CFP · 2352x1568 · 45-degree field of view.
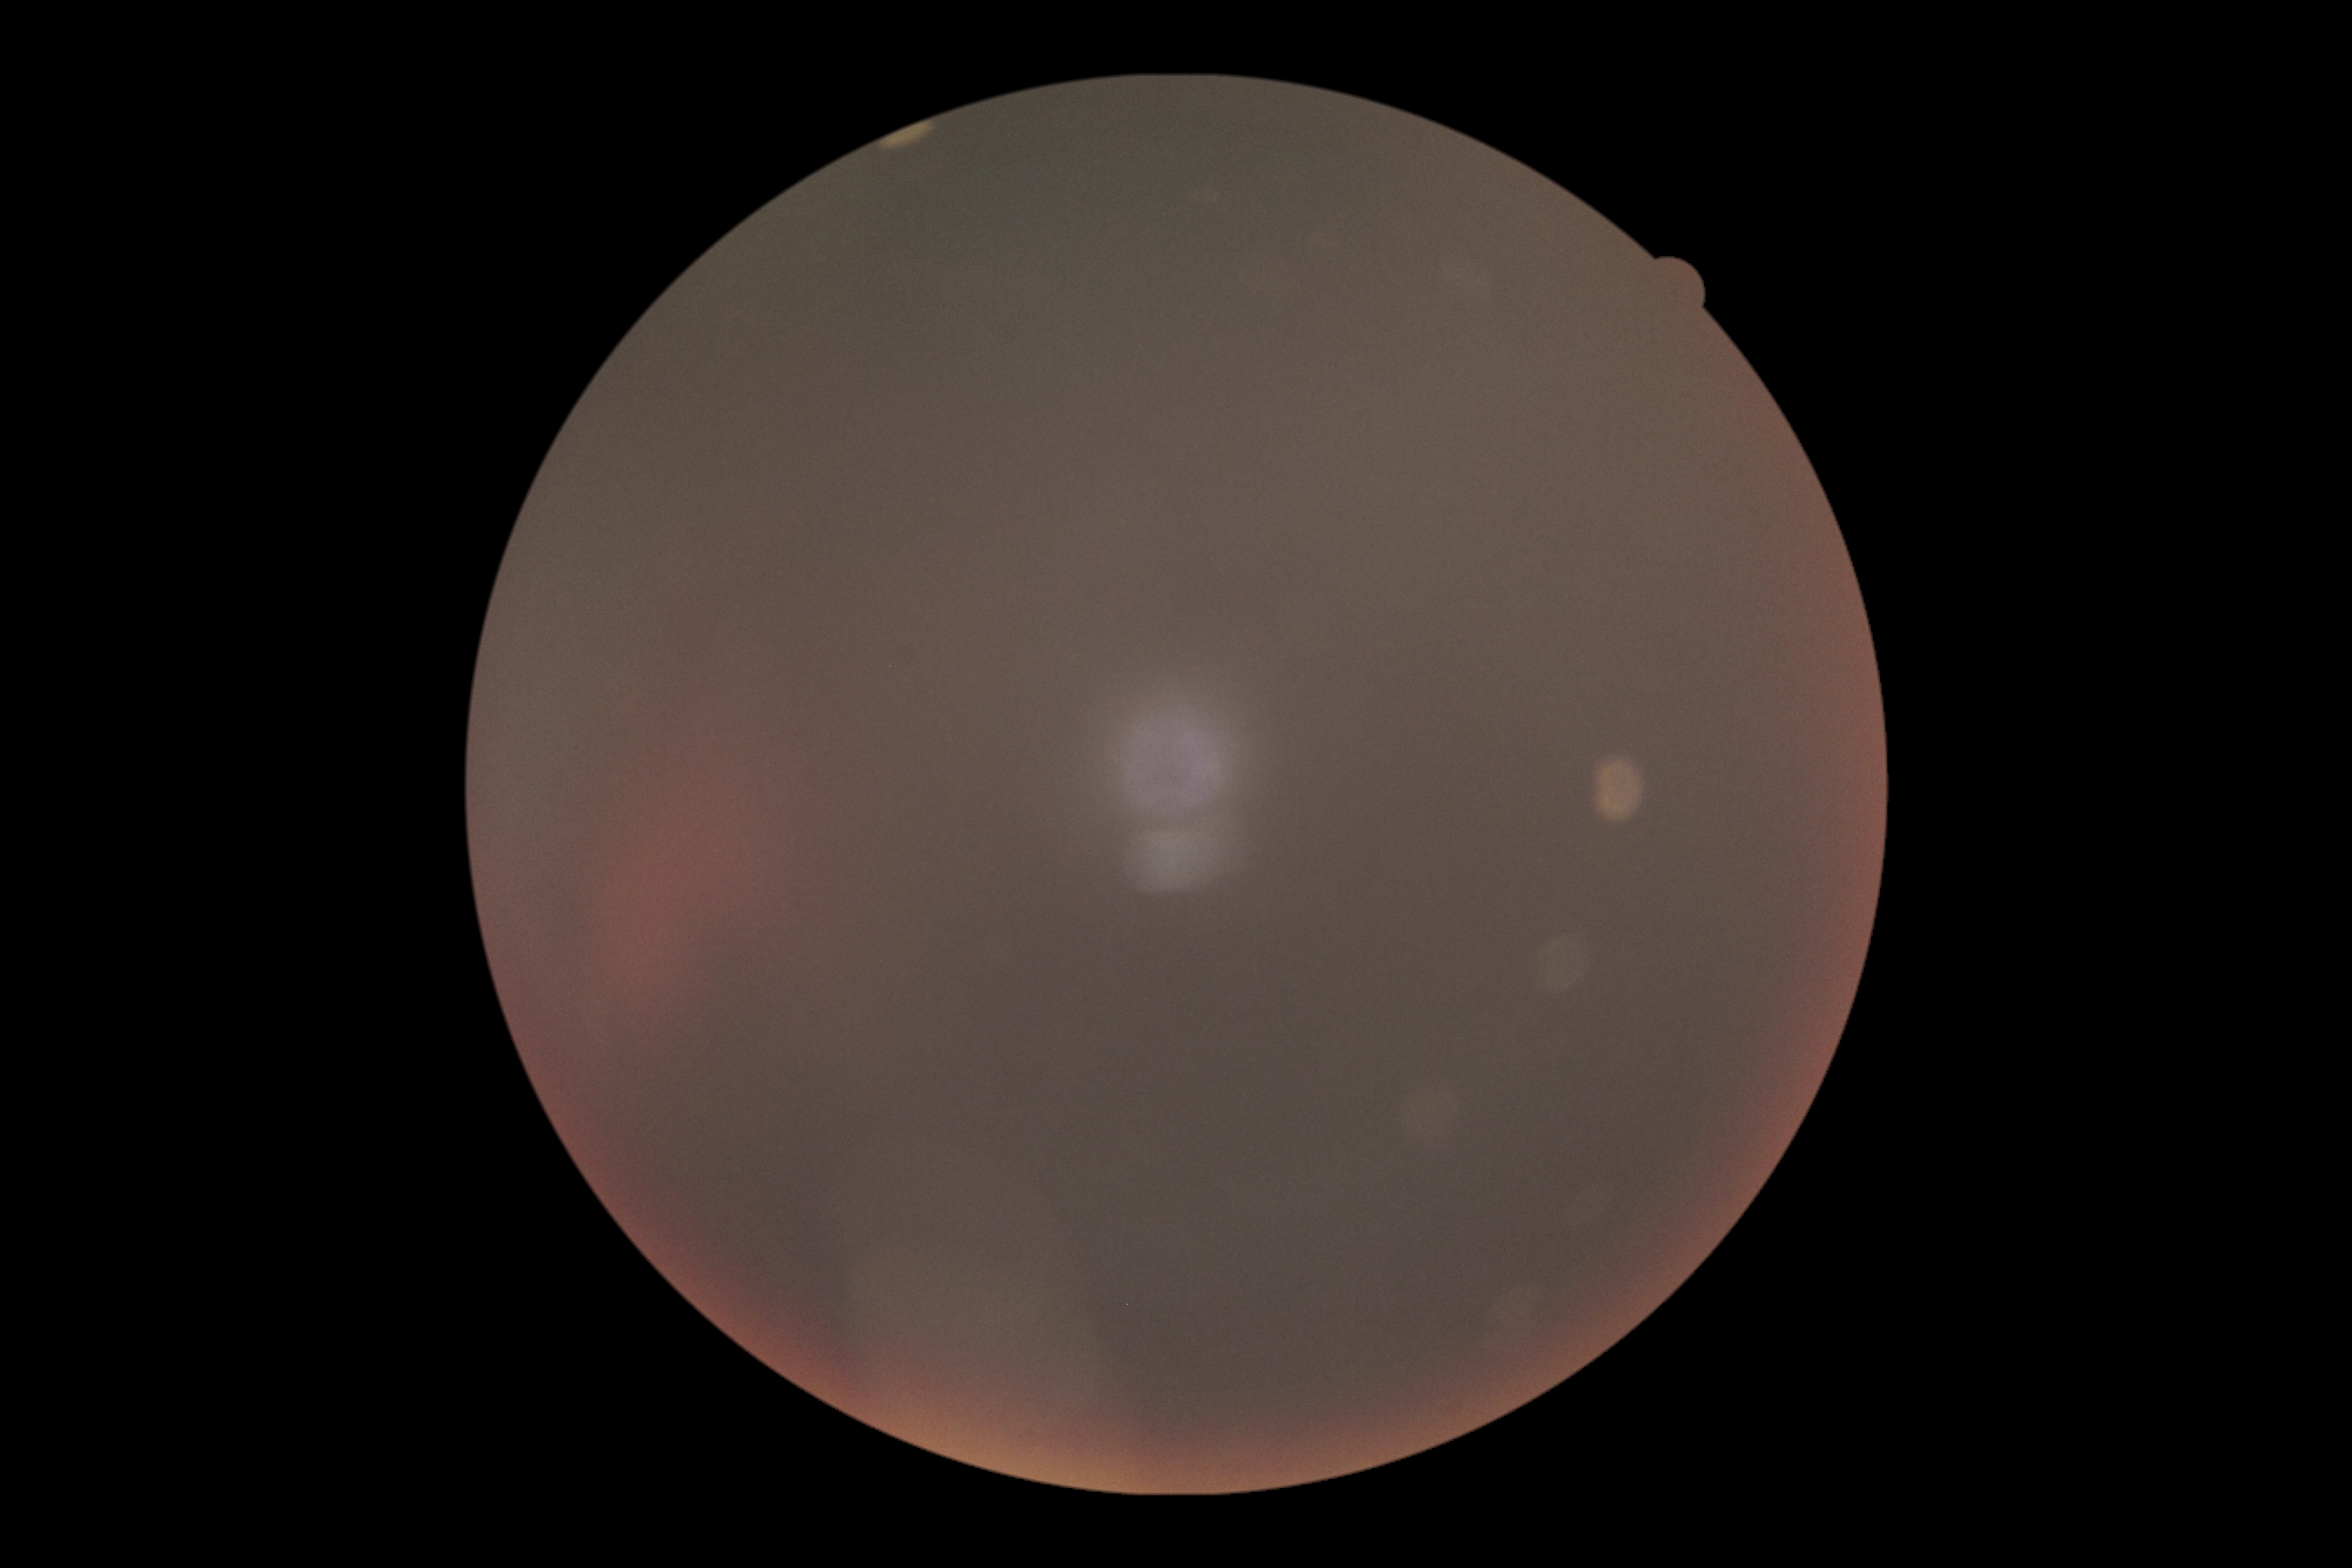 DR grade: ungradable due to poor image quality.